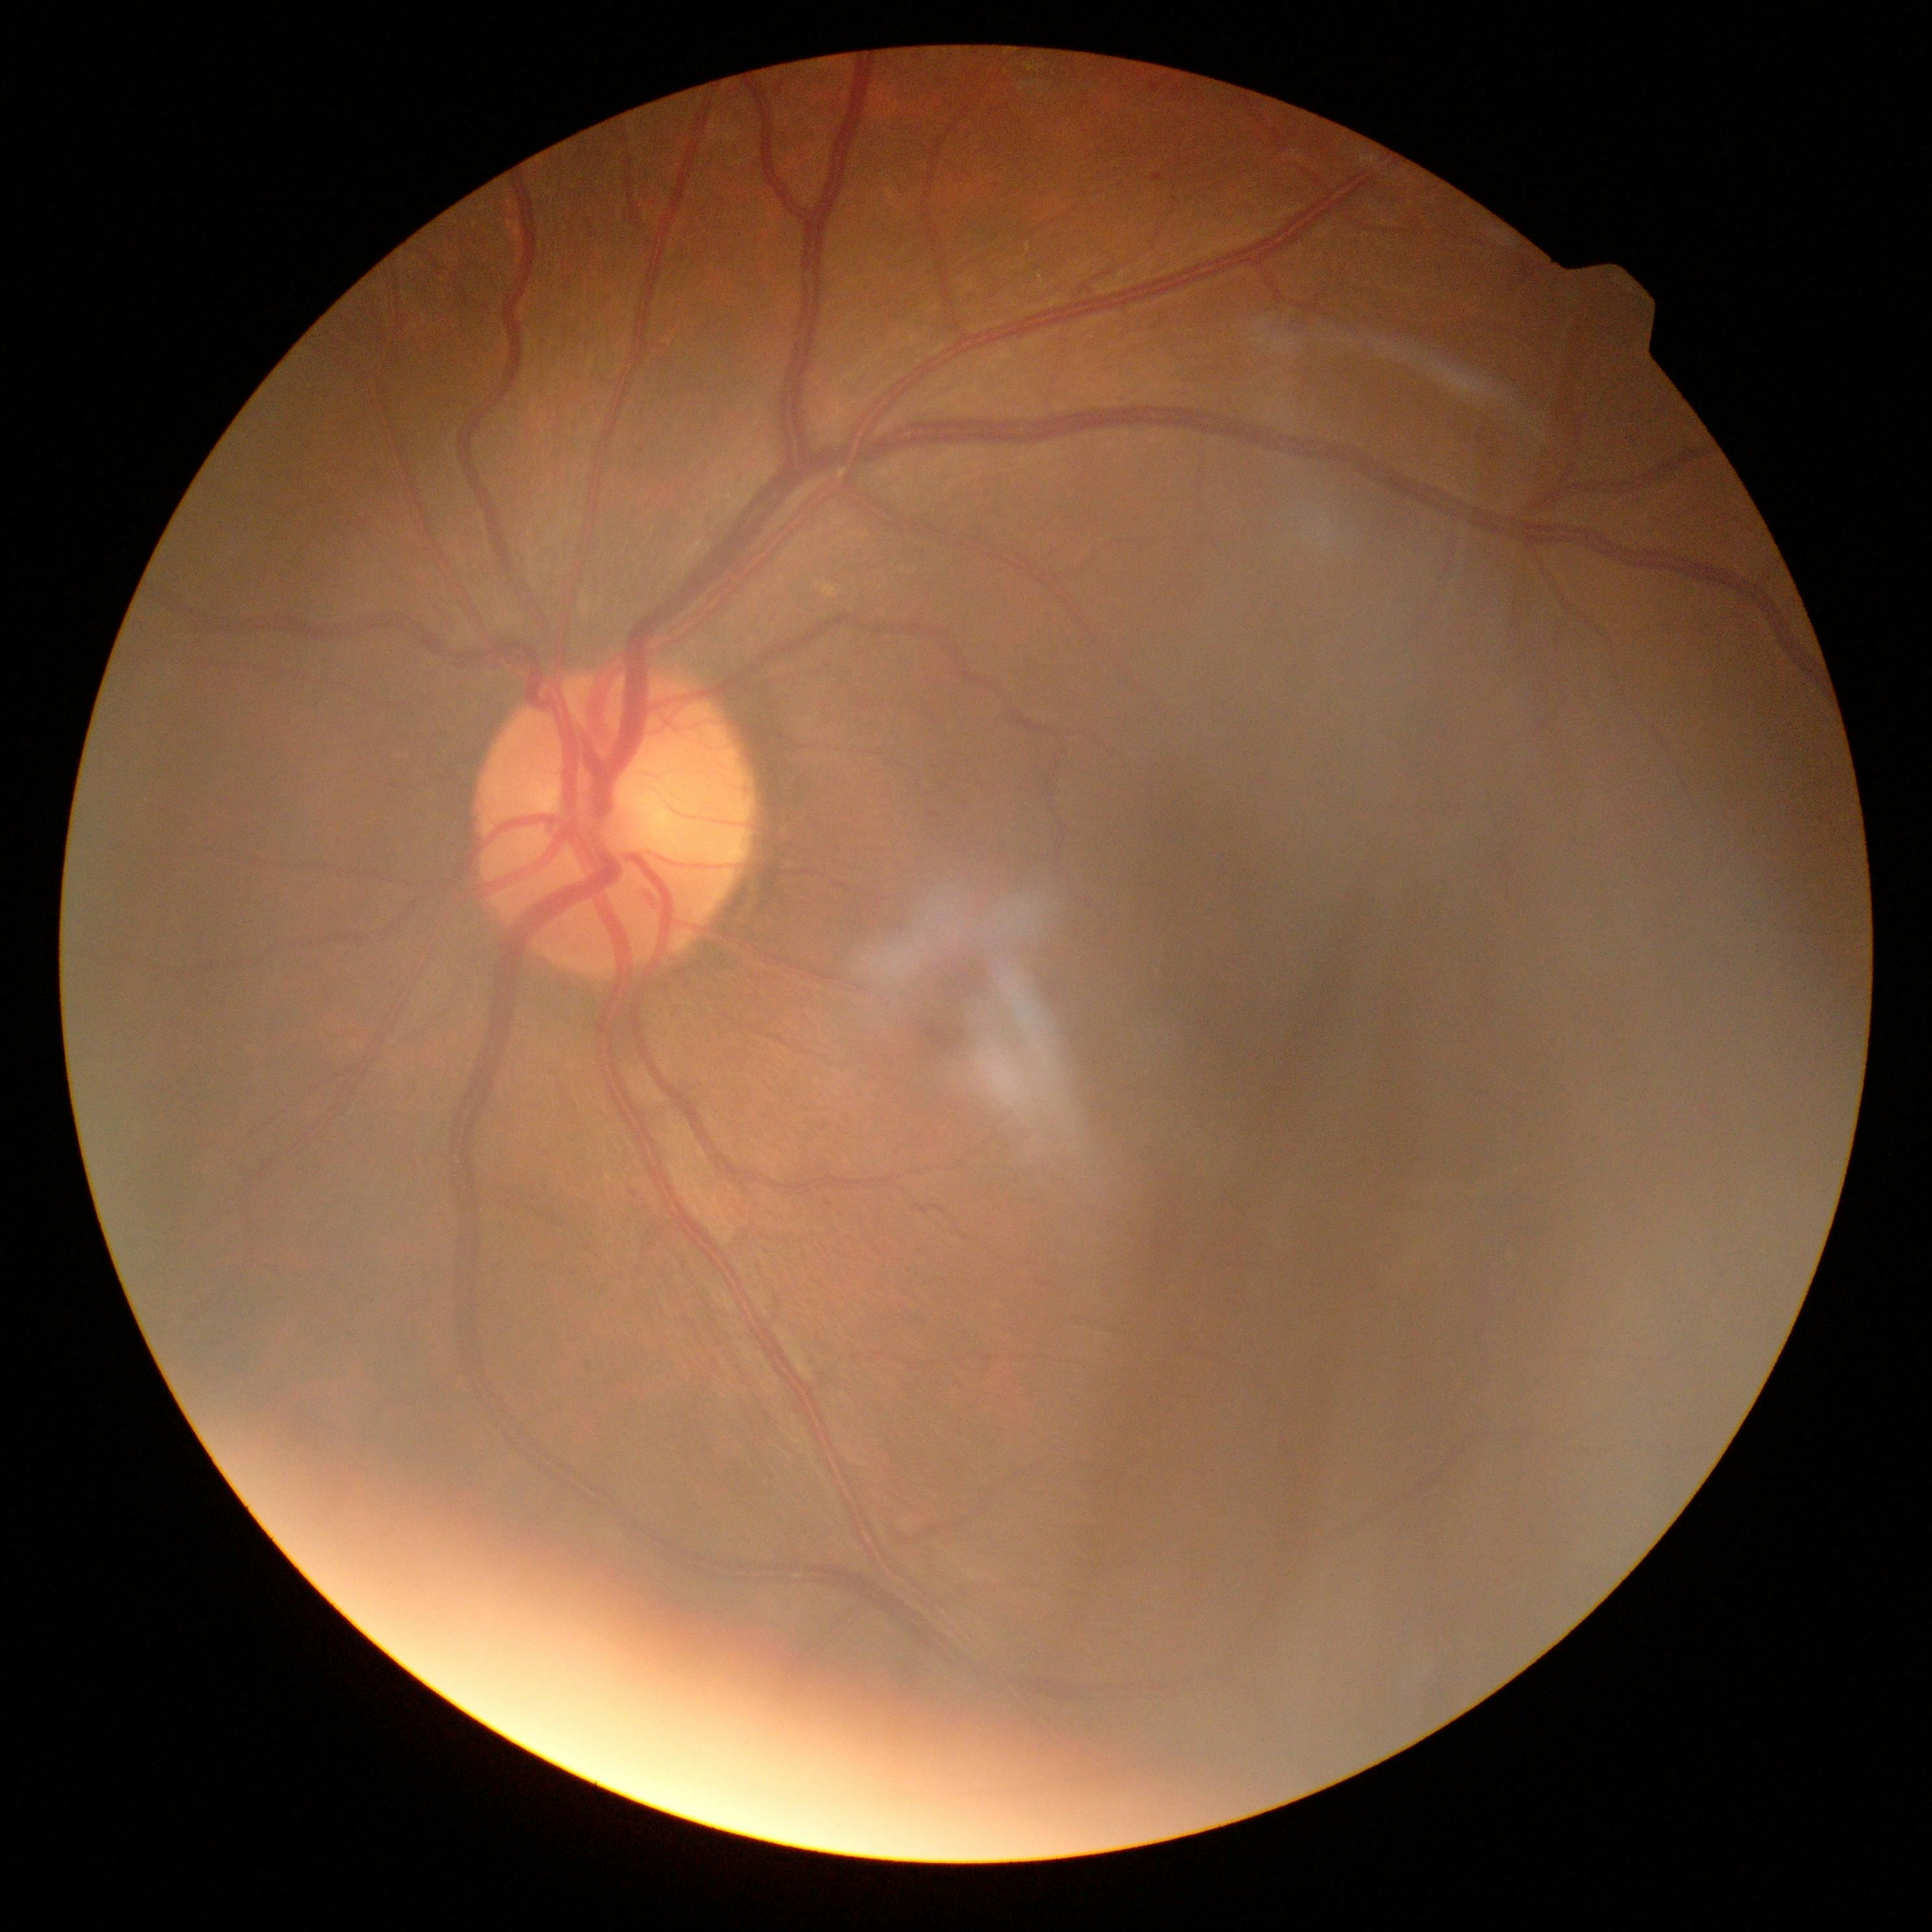
Diabetic retinopathy is moderate non-proliferative diabetic retinopathy (grade 2).